Fundus photo; 45° FOV
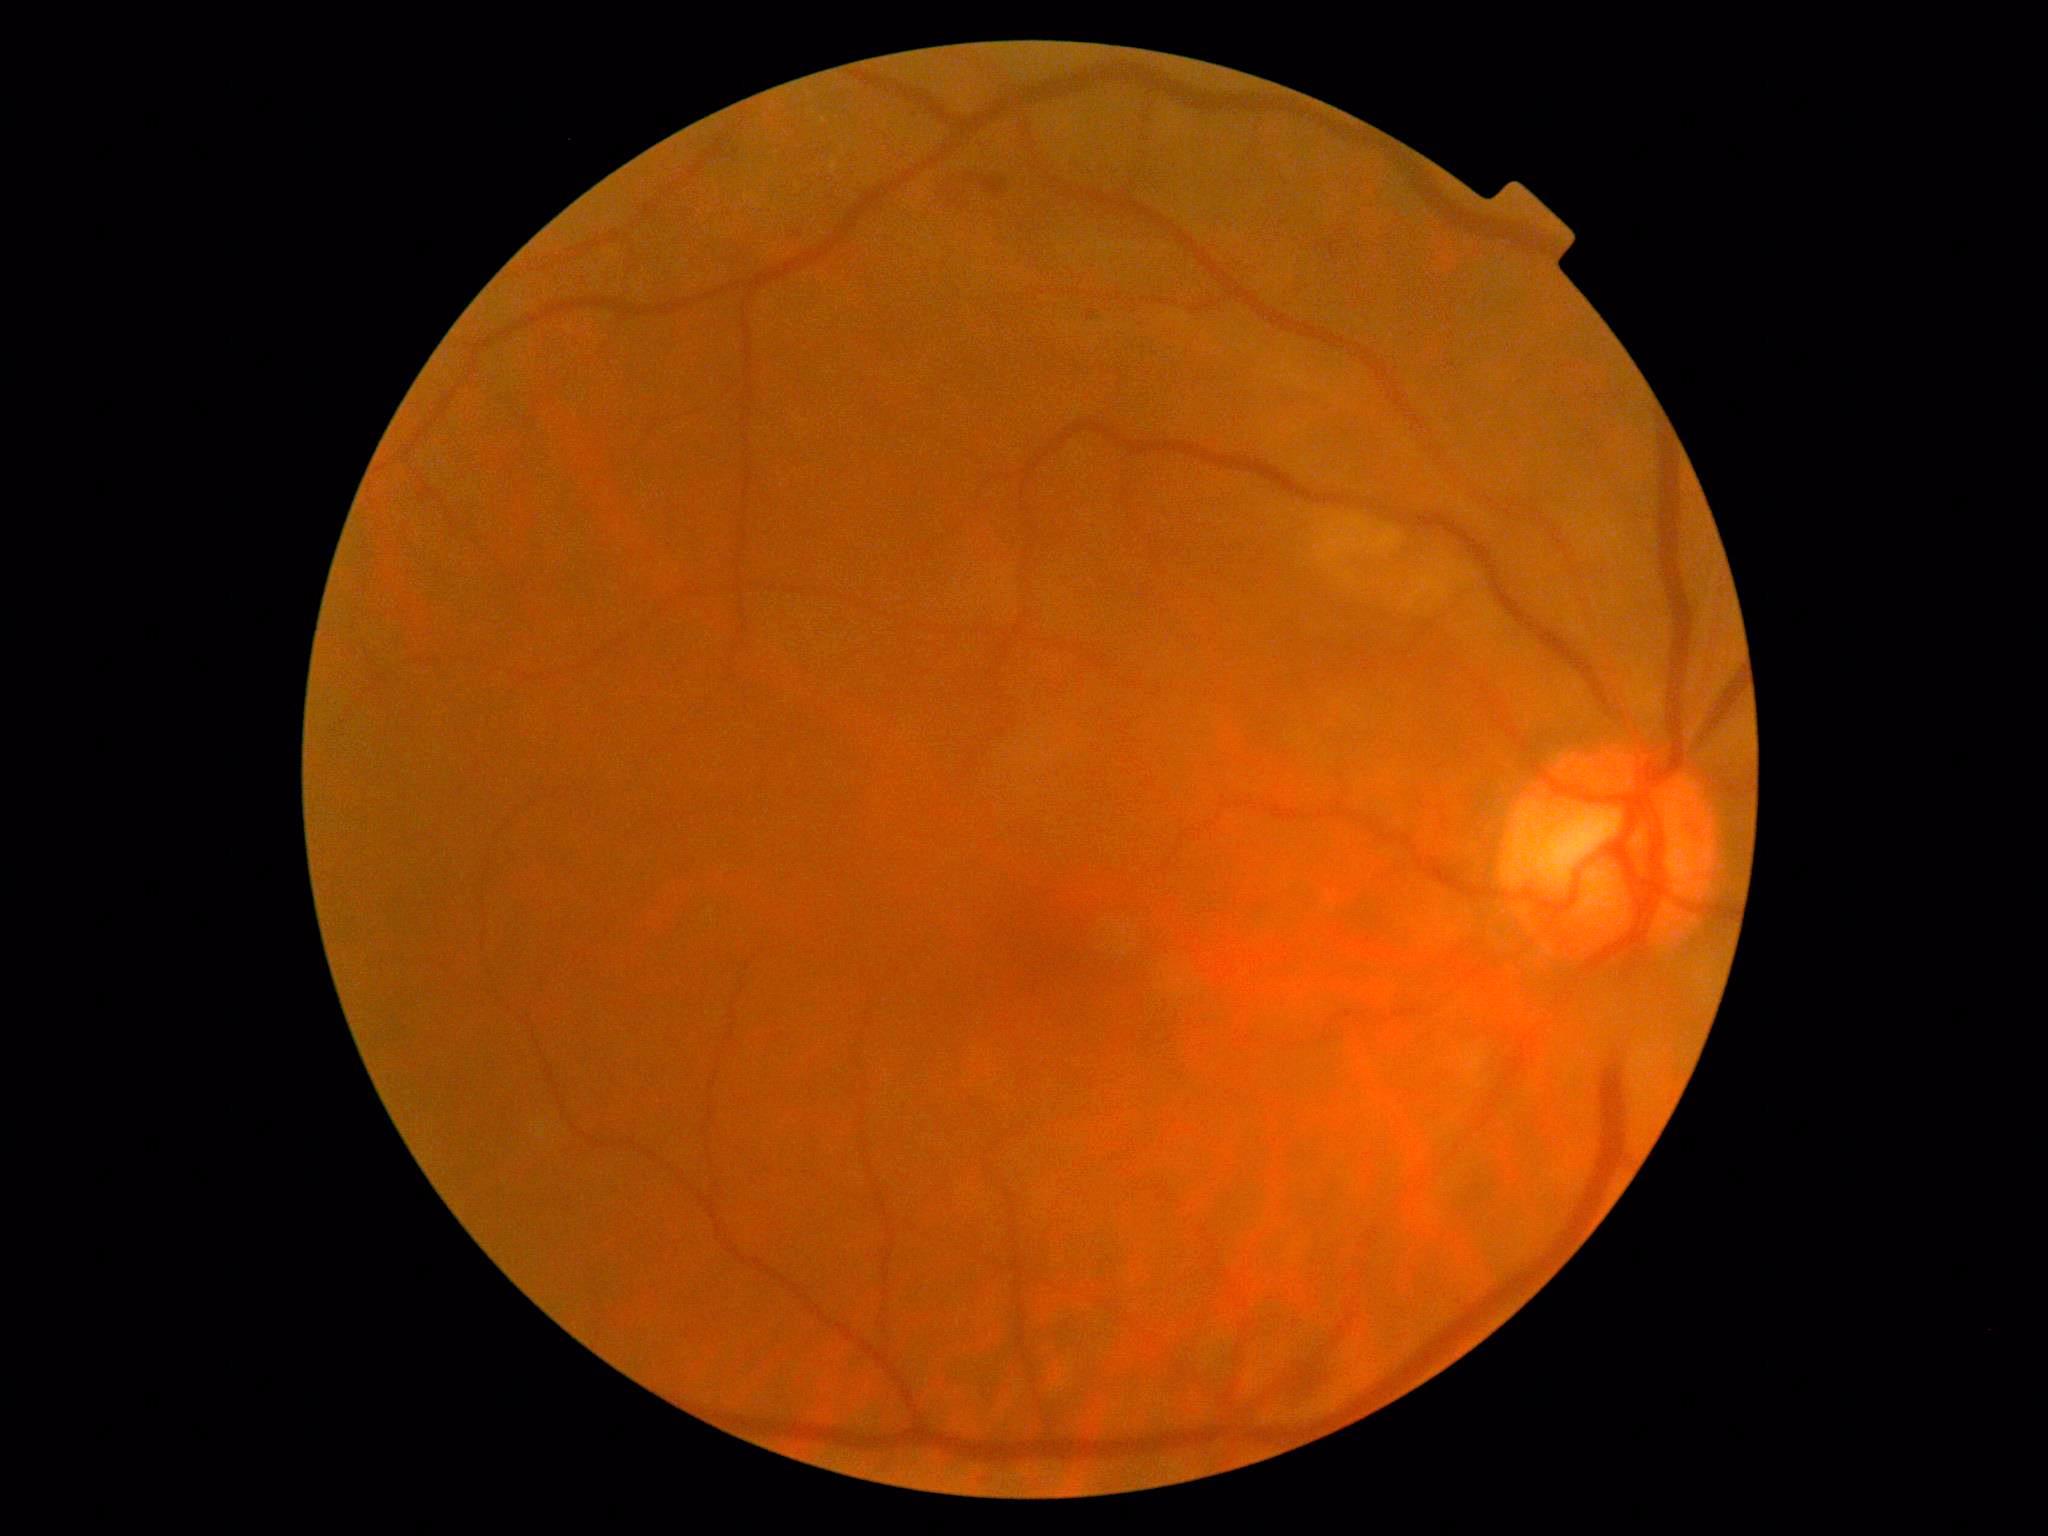 Diabetic retinopathy (DR) is 2/4.